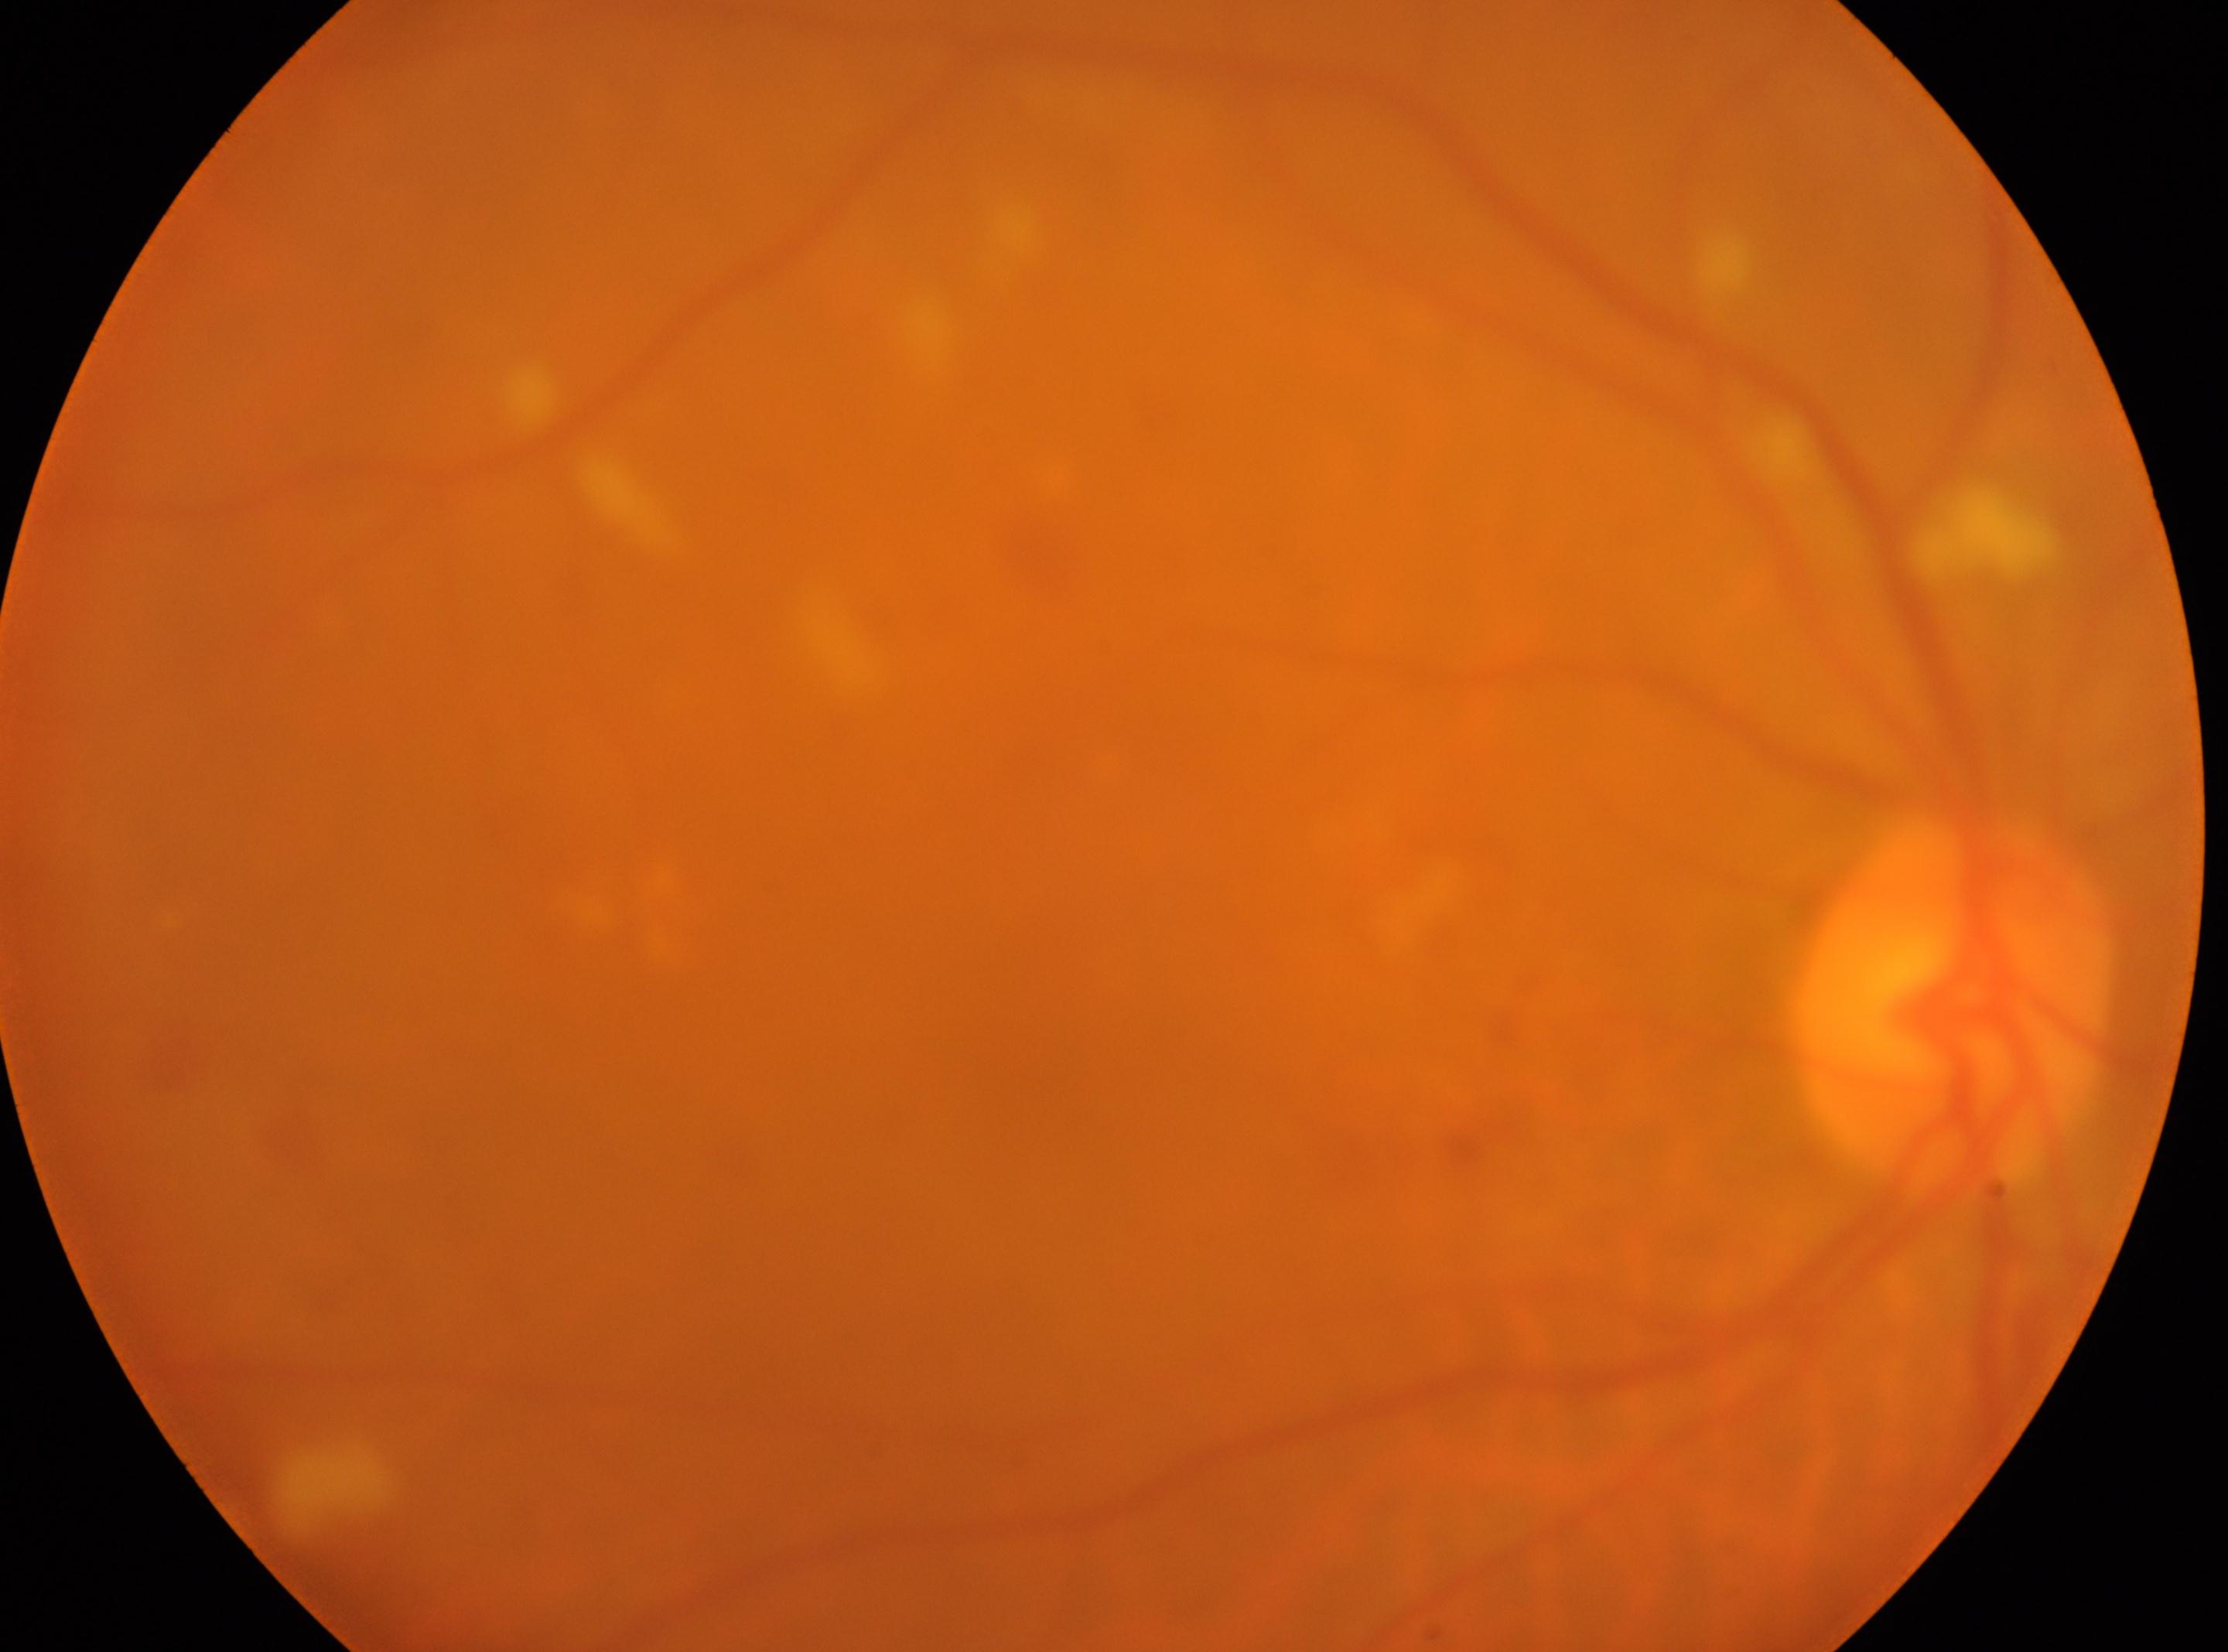
Optic disc center located at (1946,998). Fovea: (1049,1002). Eye: OD. Diabetic retinopathy: grade 2 (moderate NPDR) — more than just microaneurysms but less than severe NPDR.